Color fundus photograph · 45° FOV
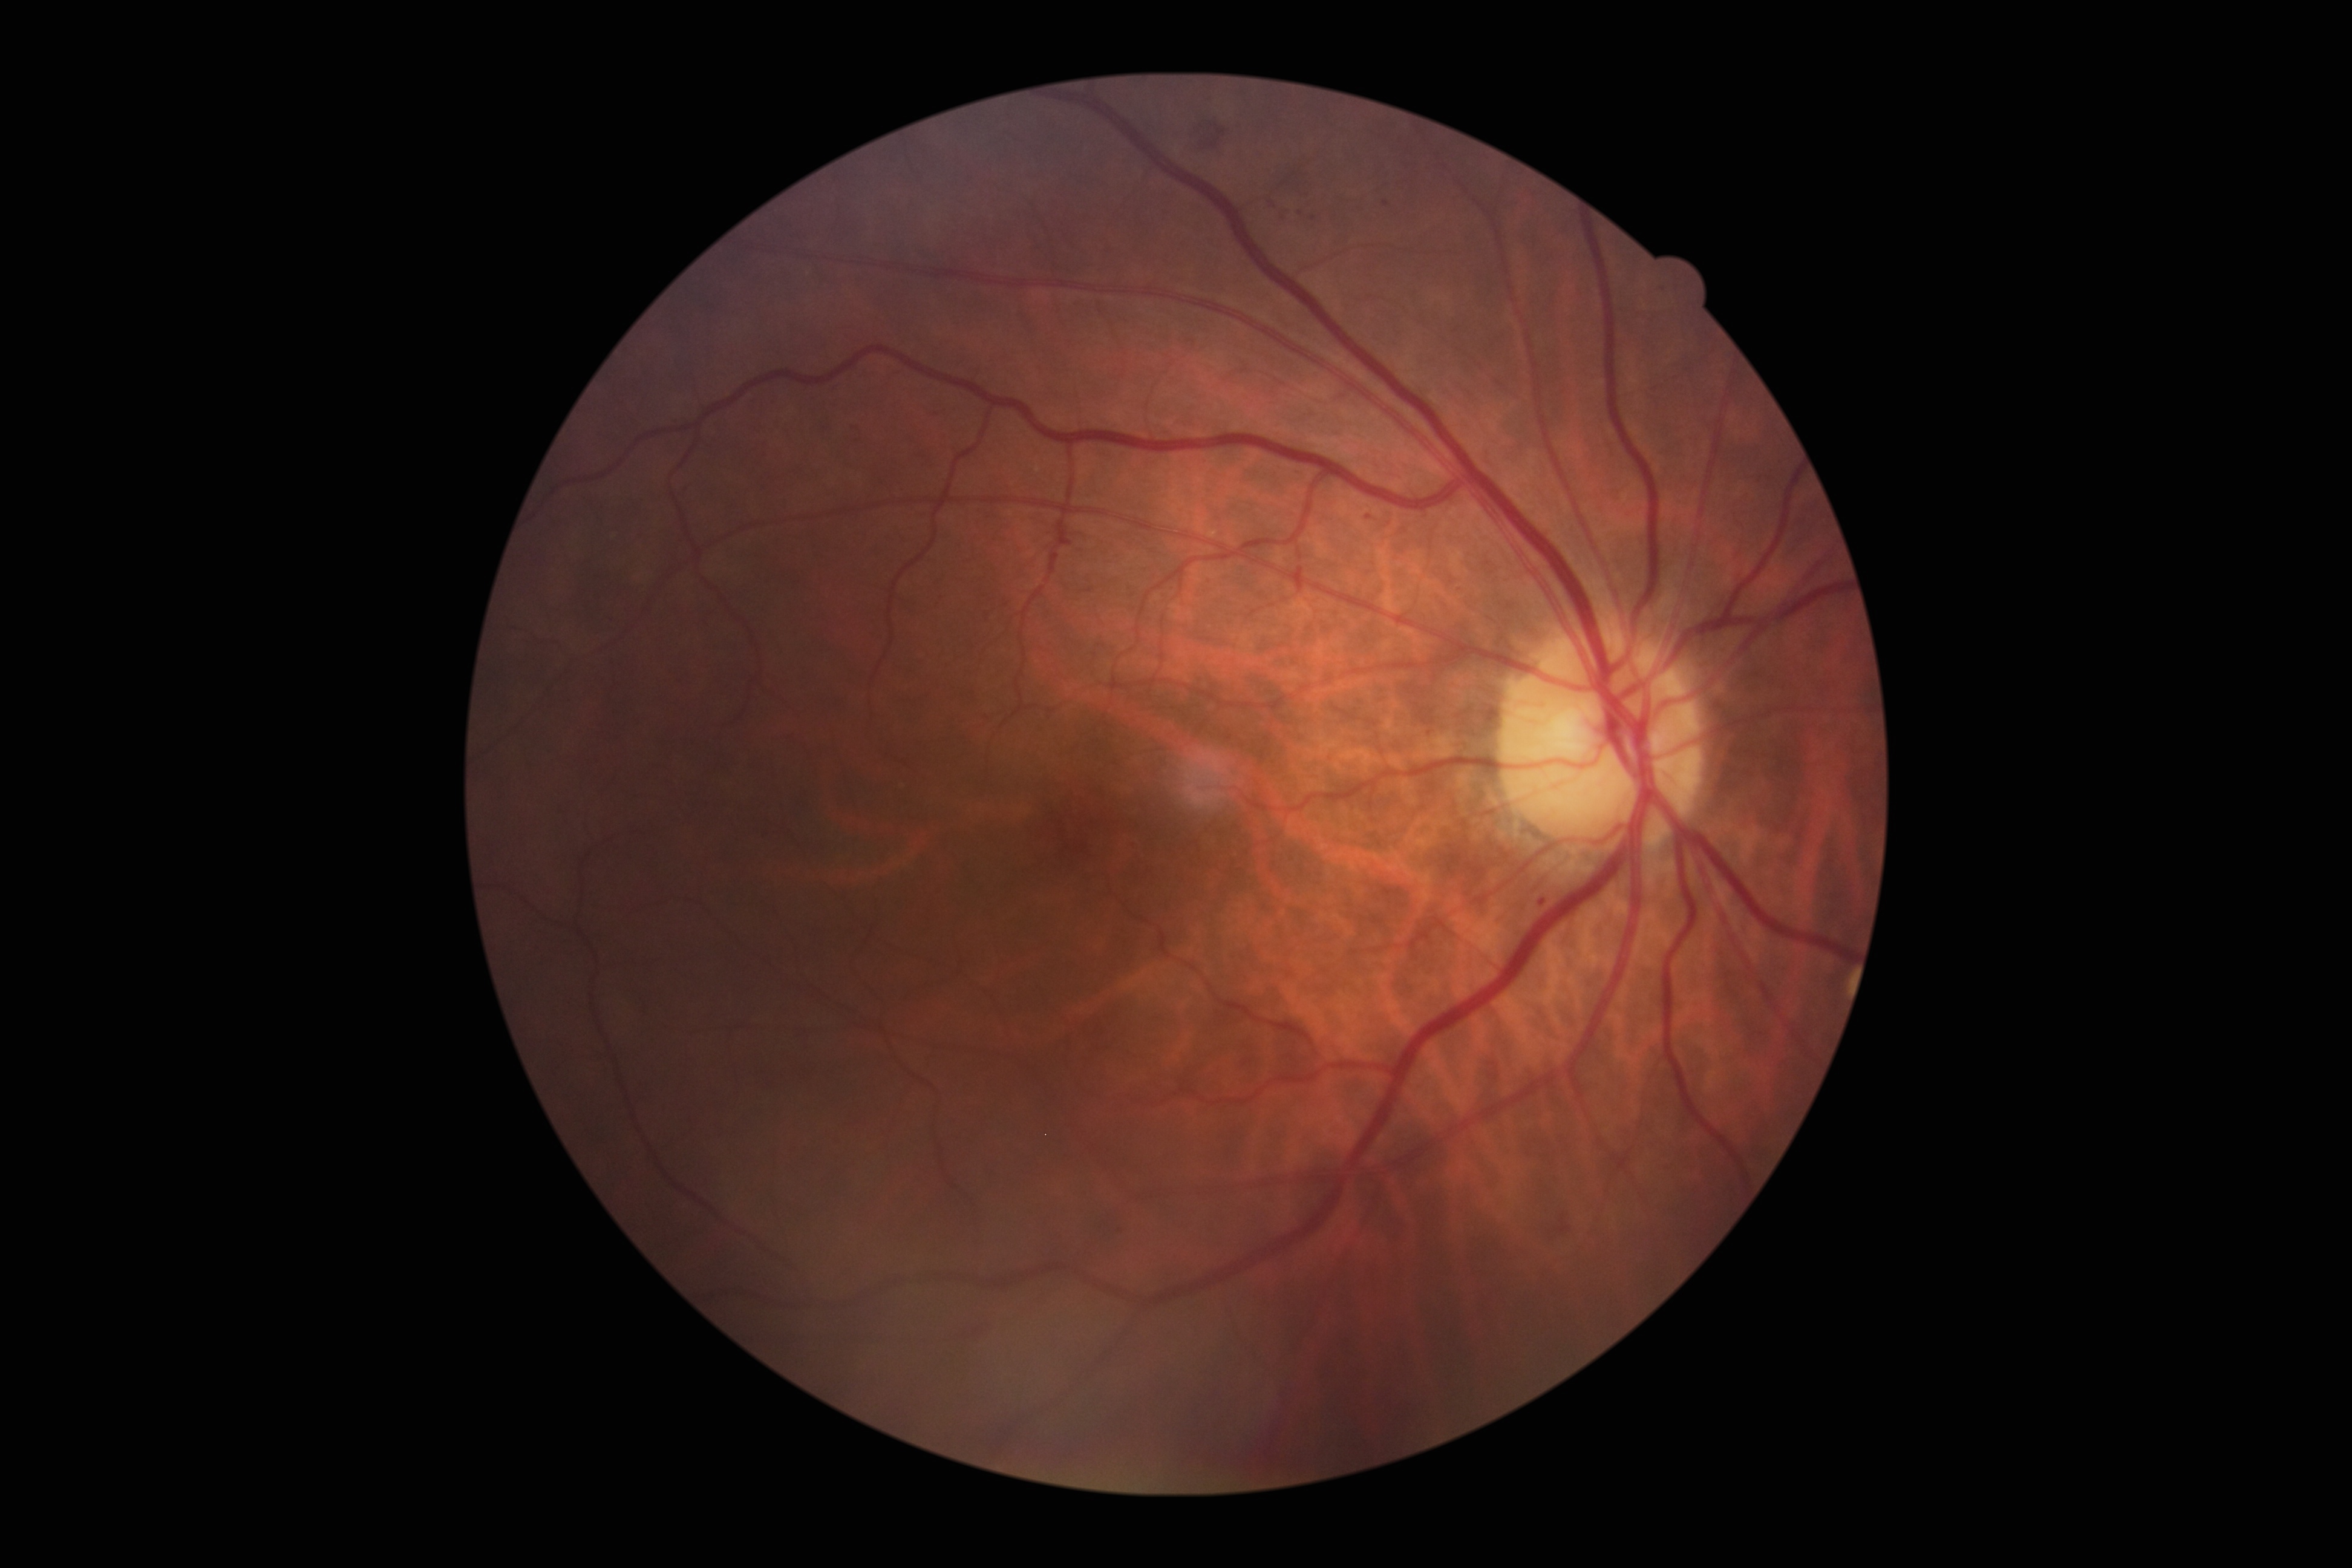

Diabetic retinopathy (DR): moderate non-proliferative diabetic retinopathy (grade 2).